Captured with the Natus RetCam Envision (130° field of view); image size 1440x1080; RetCam wide-field infant fundus image:
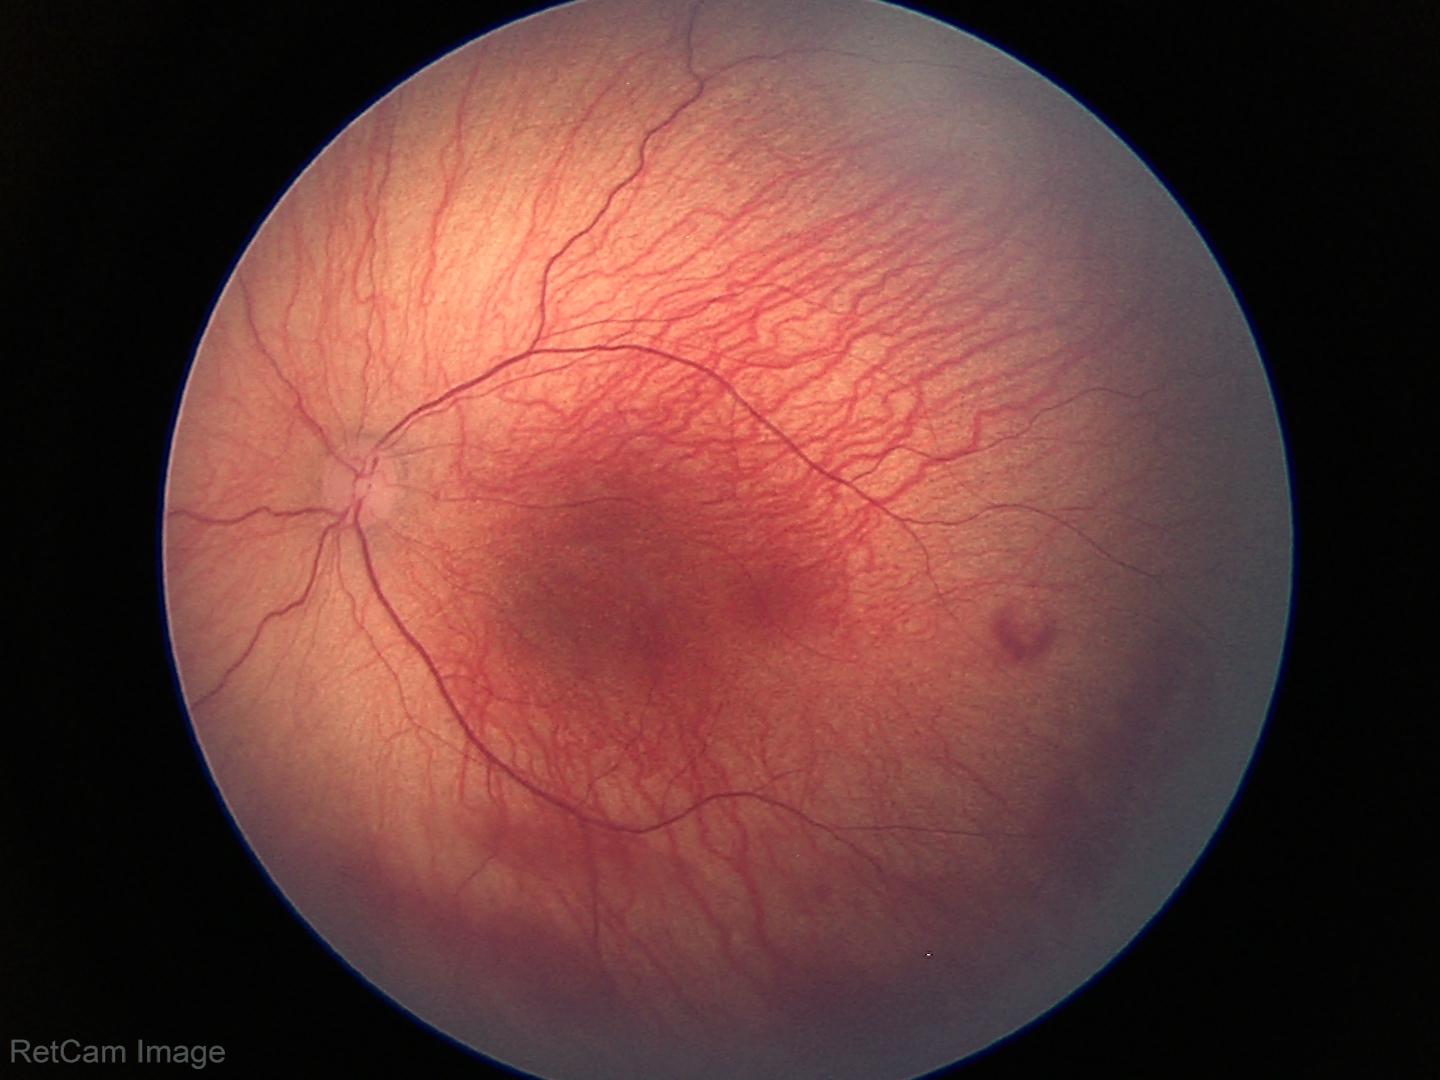
No plus disease. Diagnosis from this screening exam: retinopathy of prematurity stage 1.